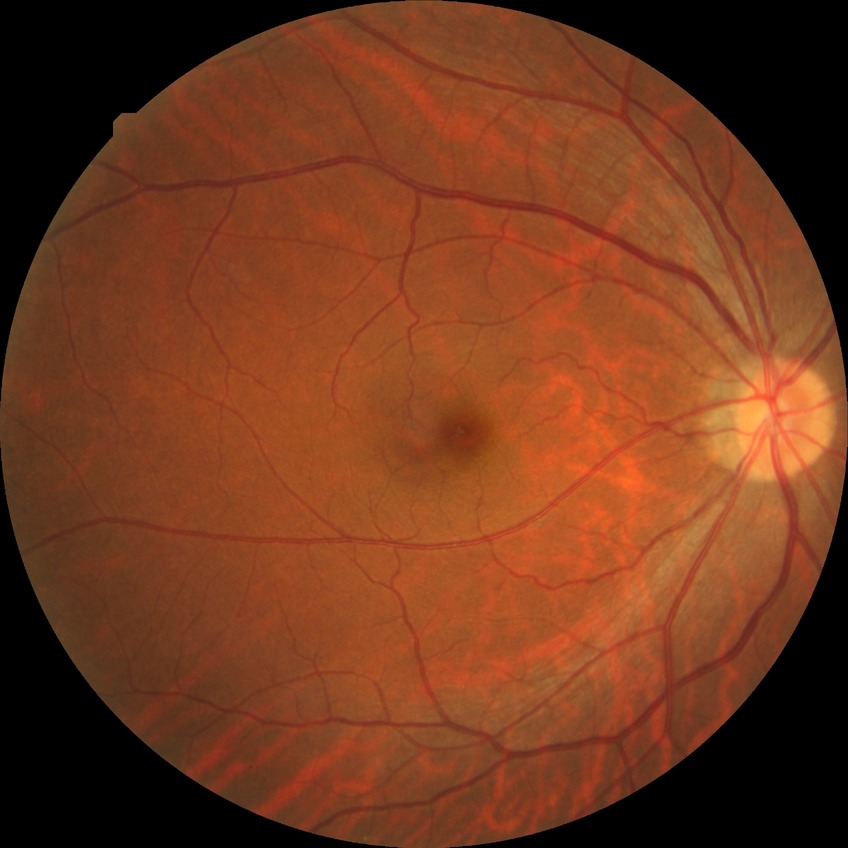 Findings:
- DR: NDR